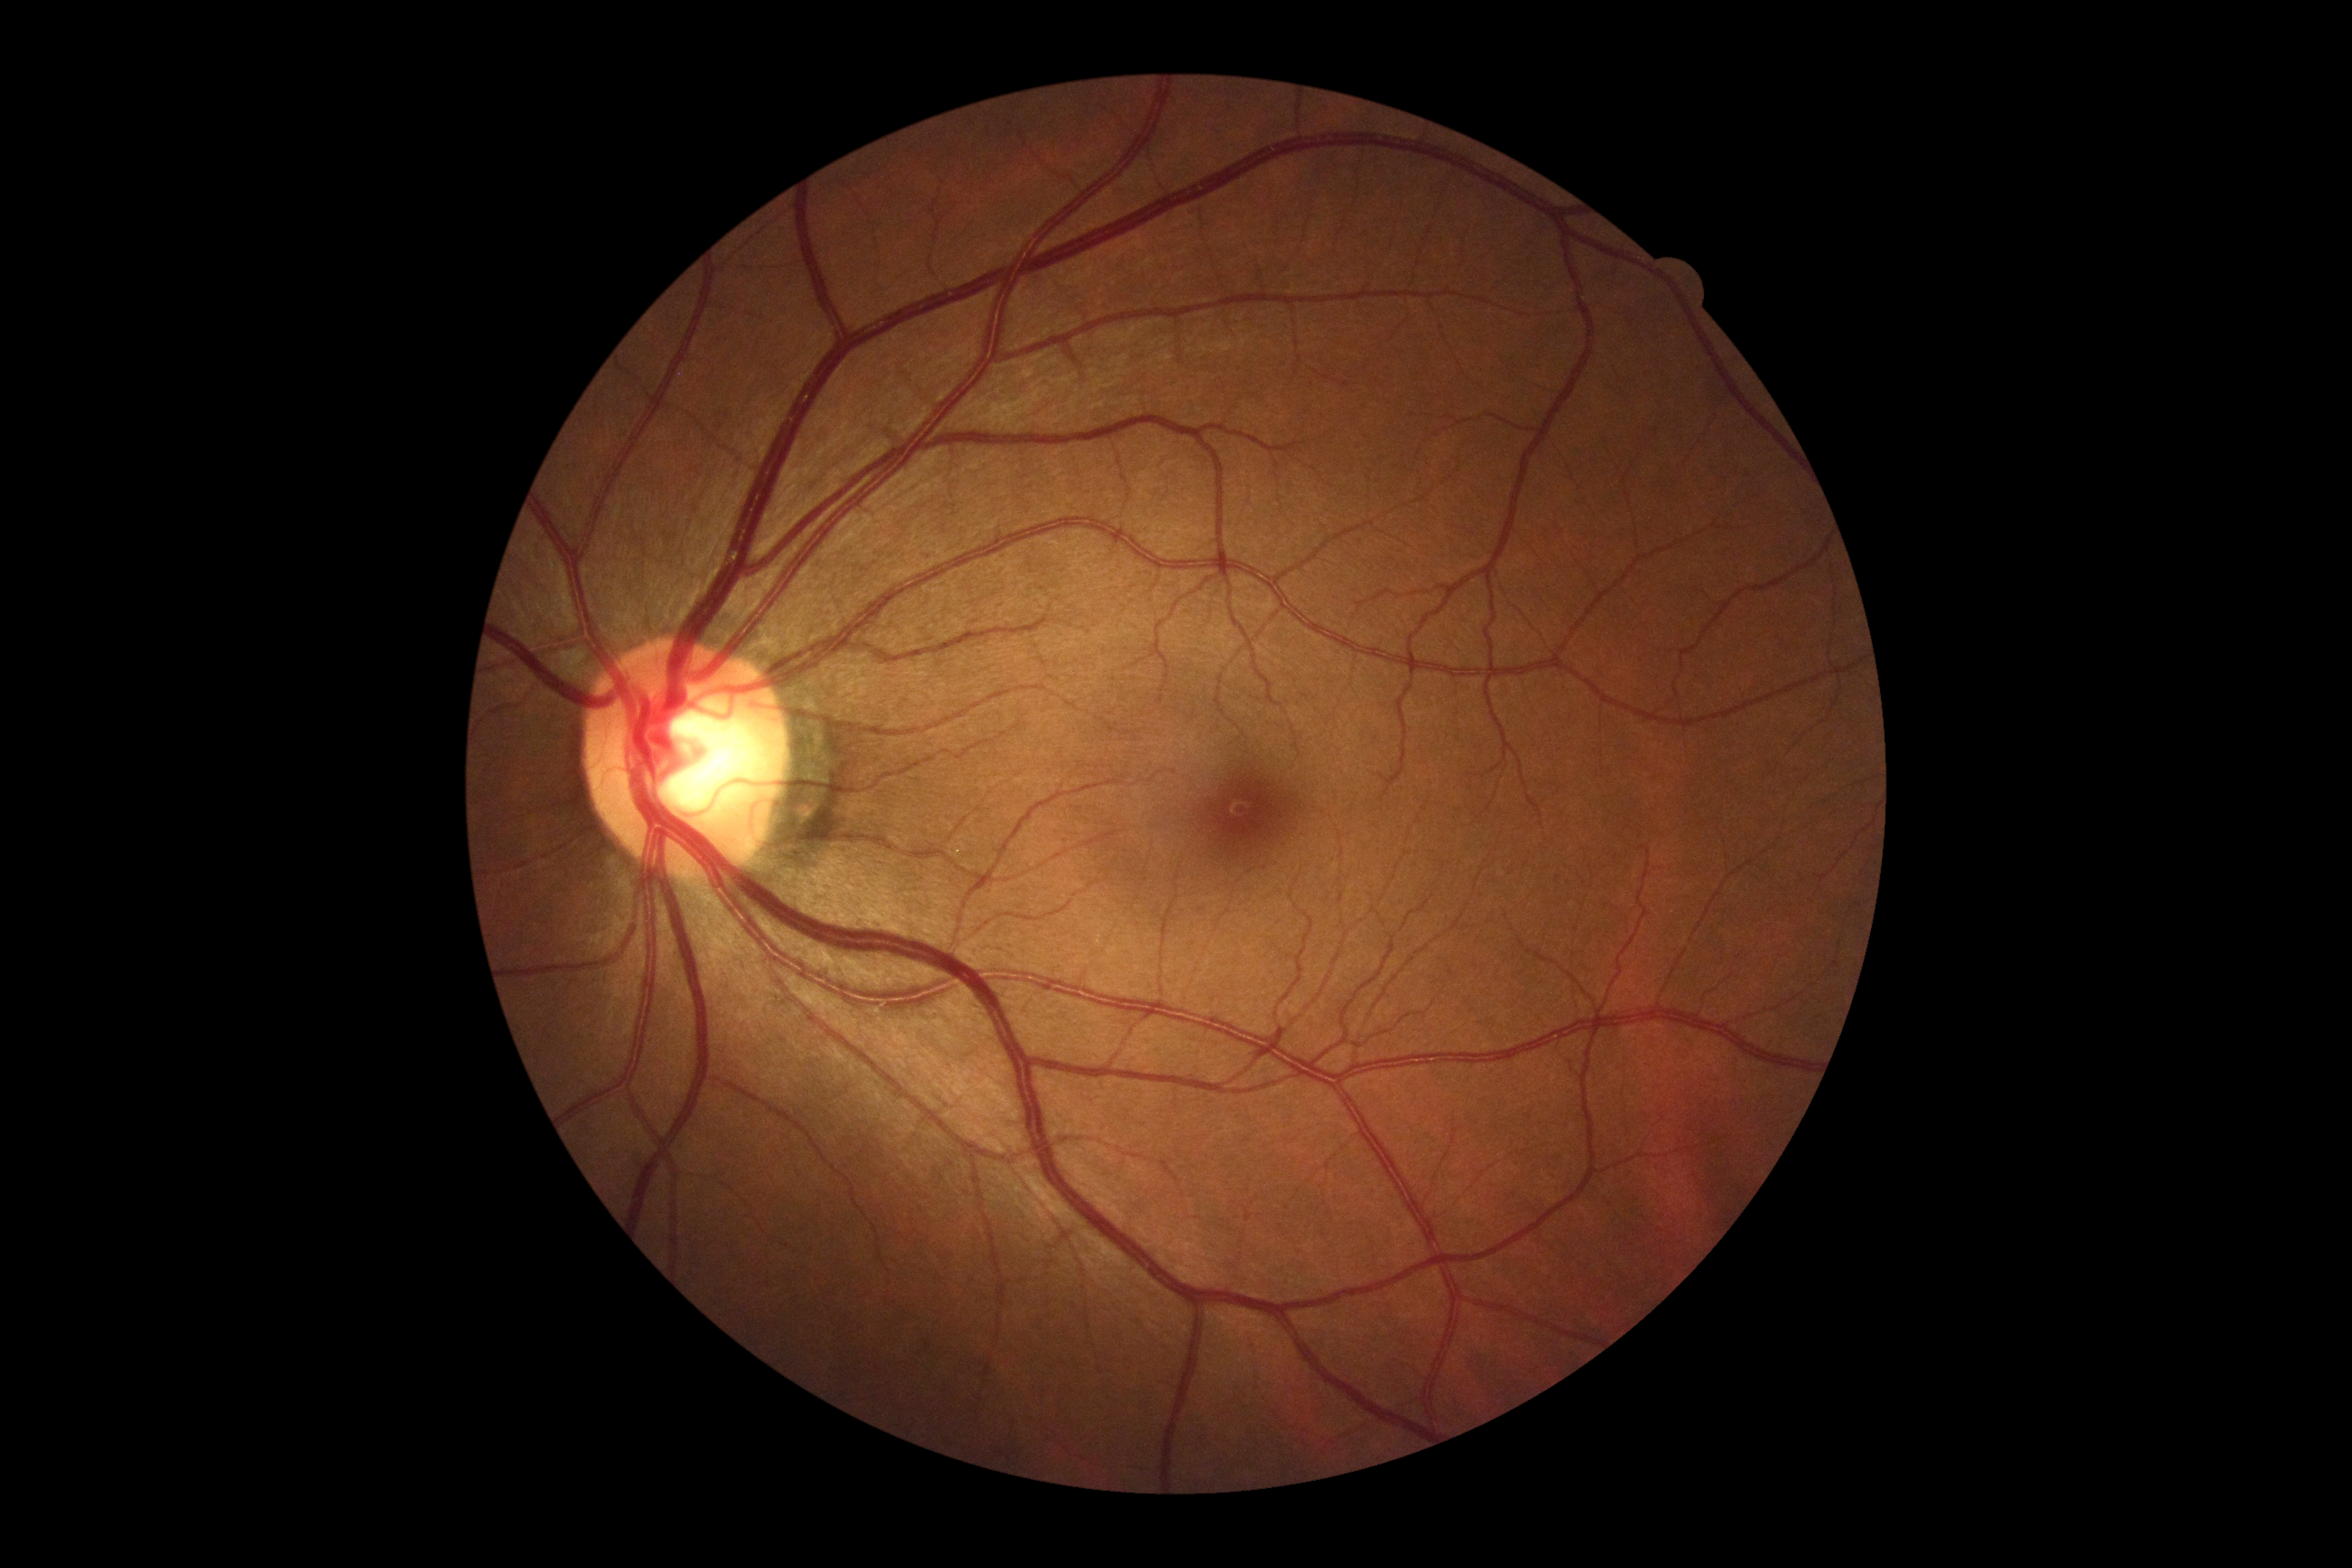 Findings:
• DR severity — 0